1240x1240. Wide-field fundus photograph of an infant. Phoenix ICON, 100° FOV.
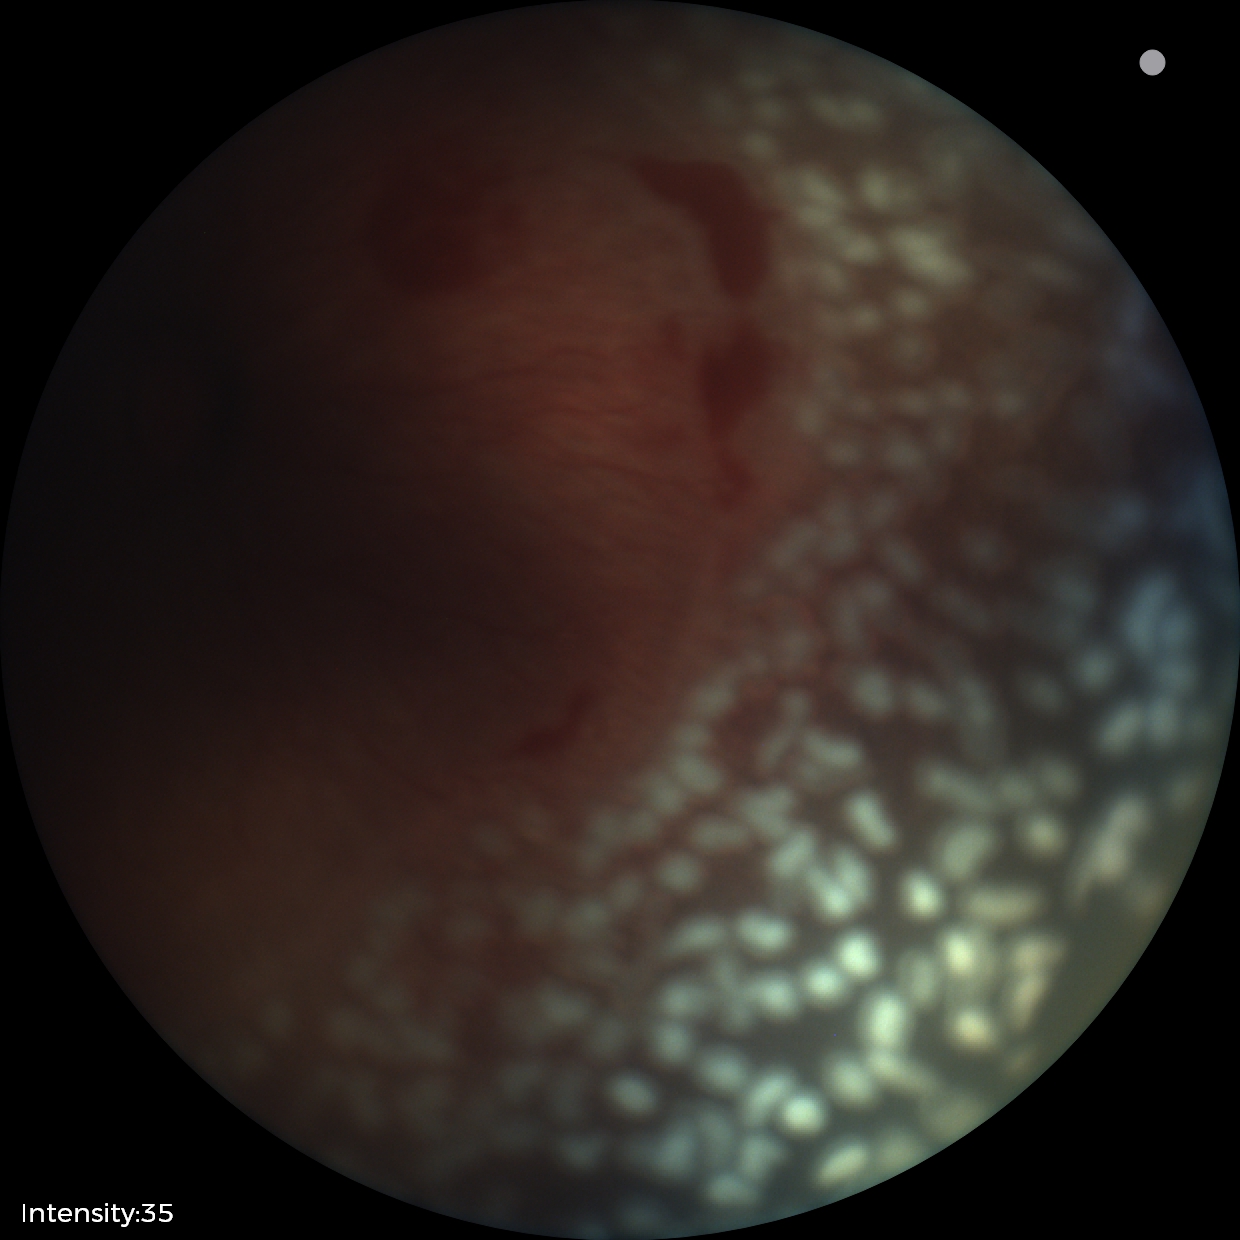

ROP diagnosis: stage 2; plus disease: present.